45° field of view. CFP. Image size 2212x1659
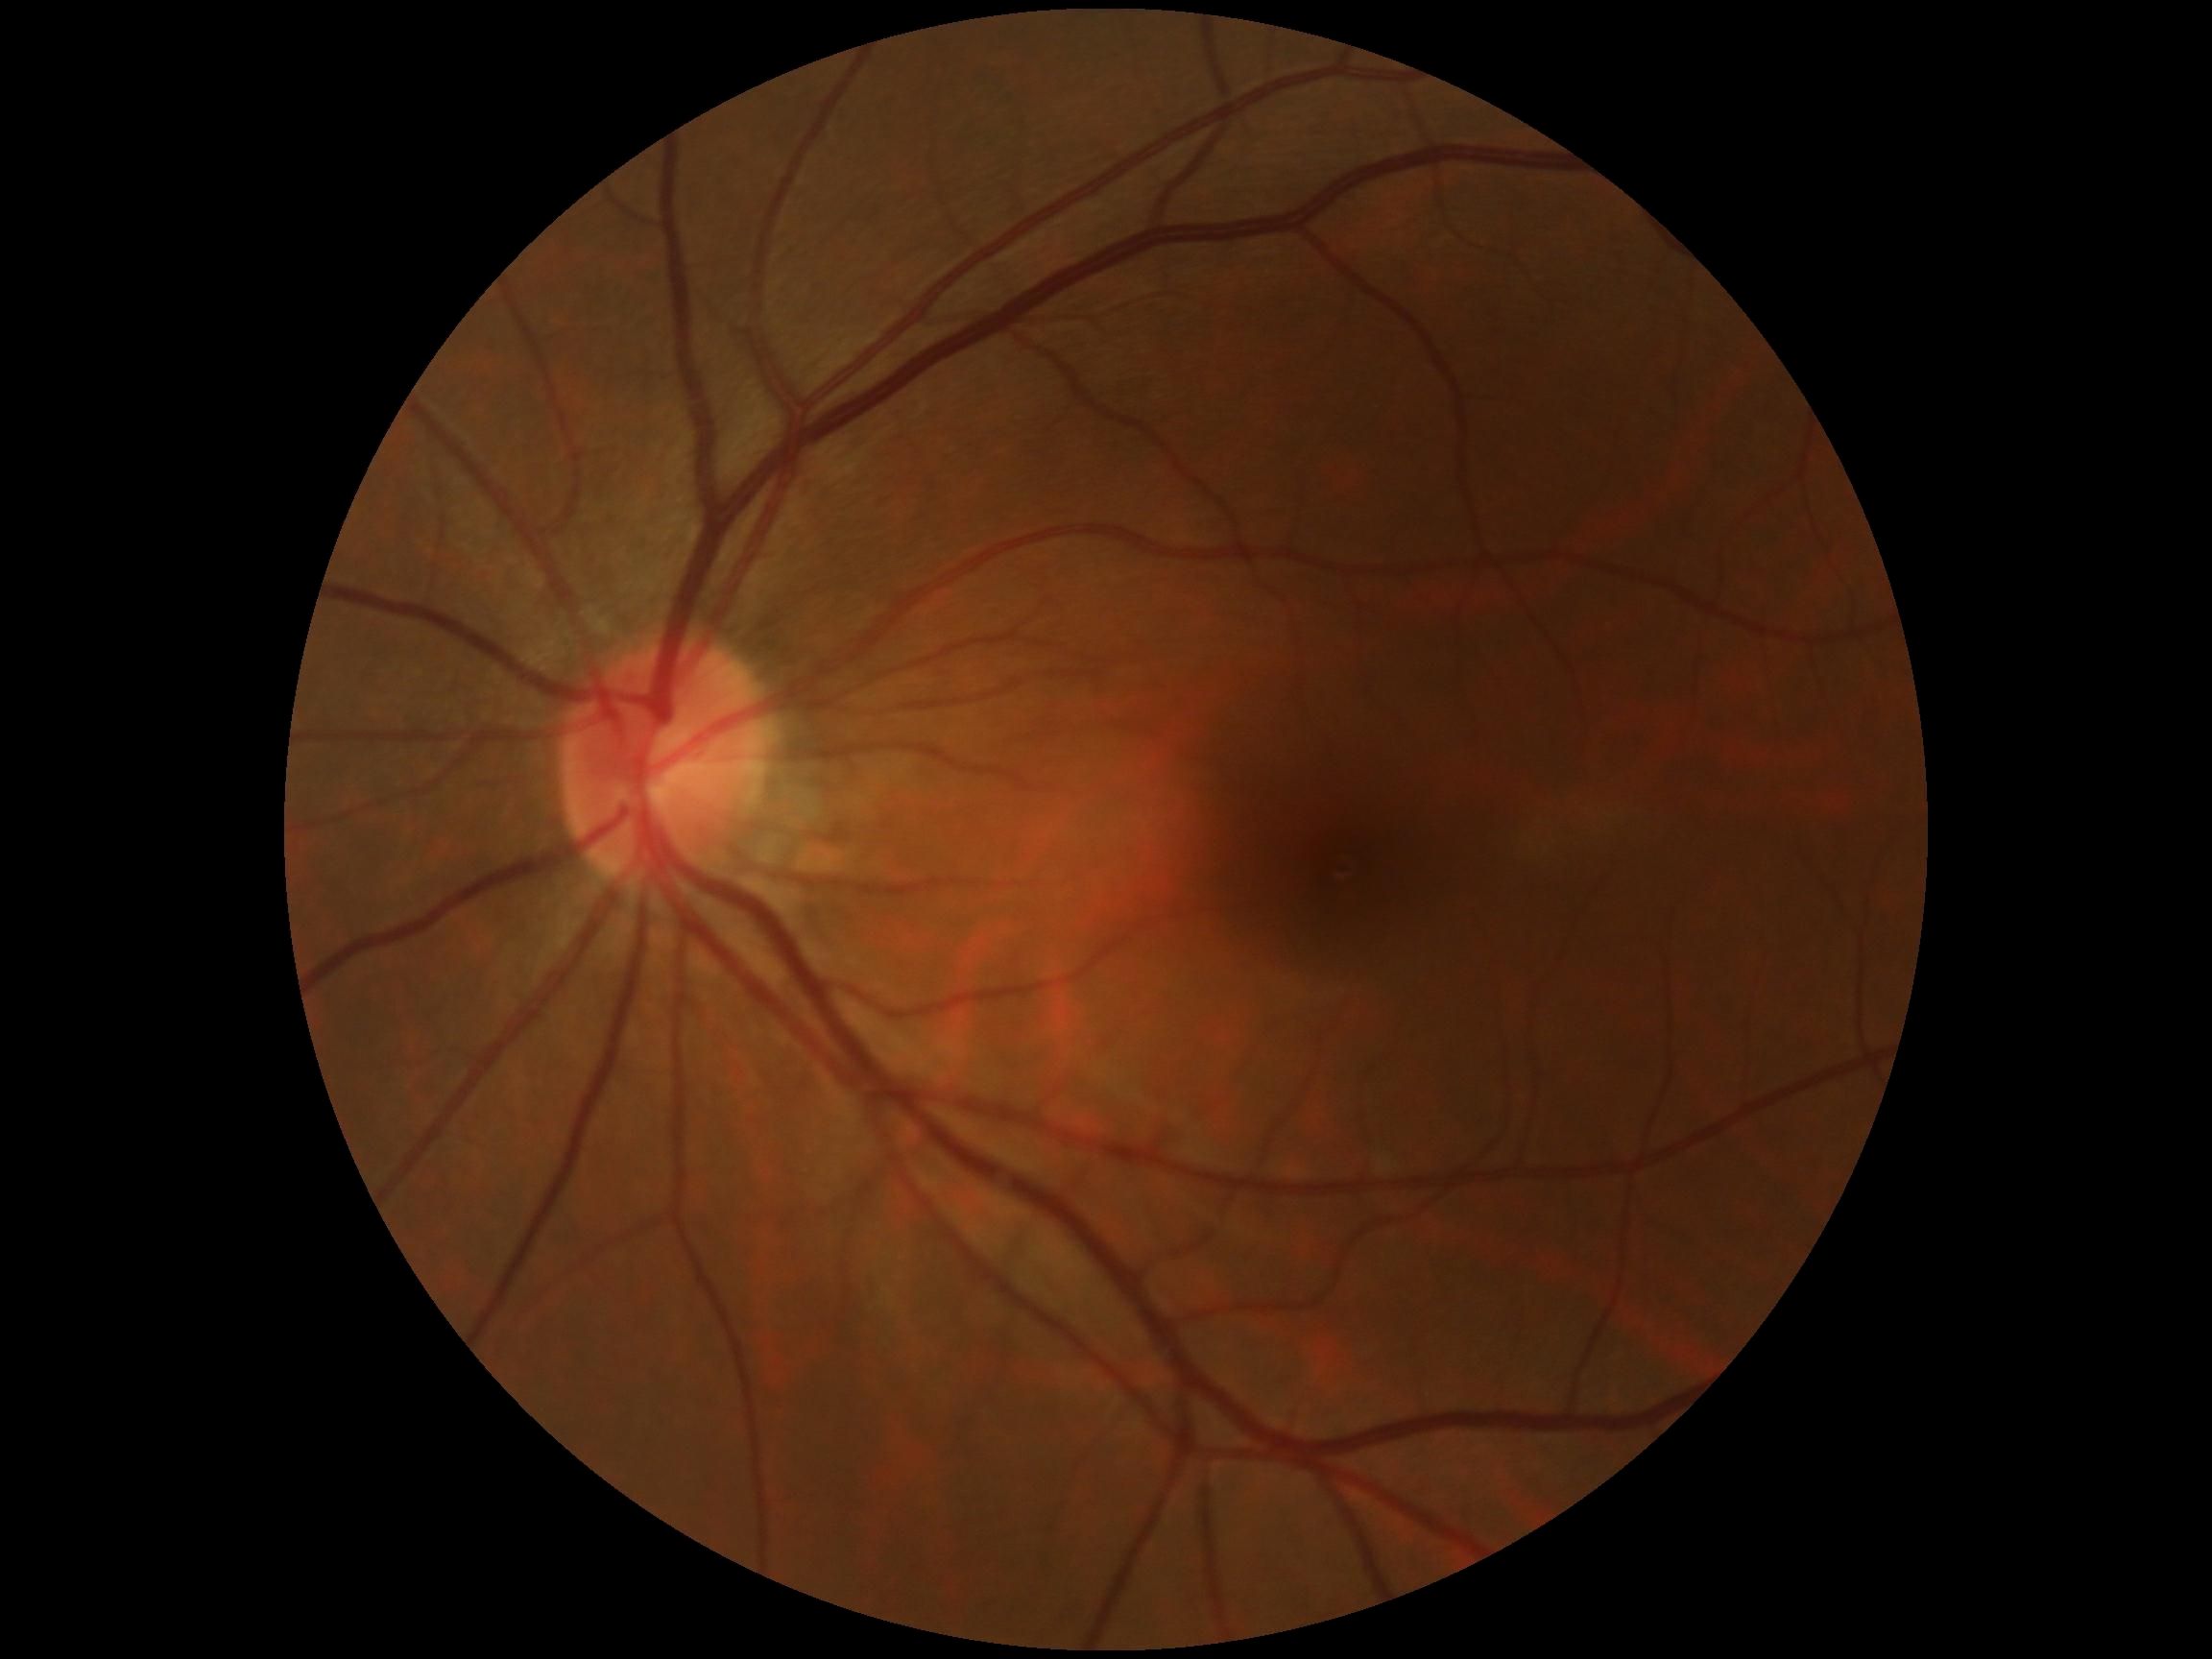

- diabetic retinopathy: no apparent retinopathy (grade 0)